45-degree field of view
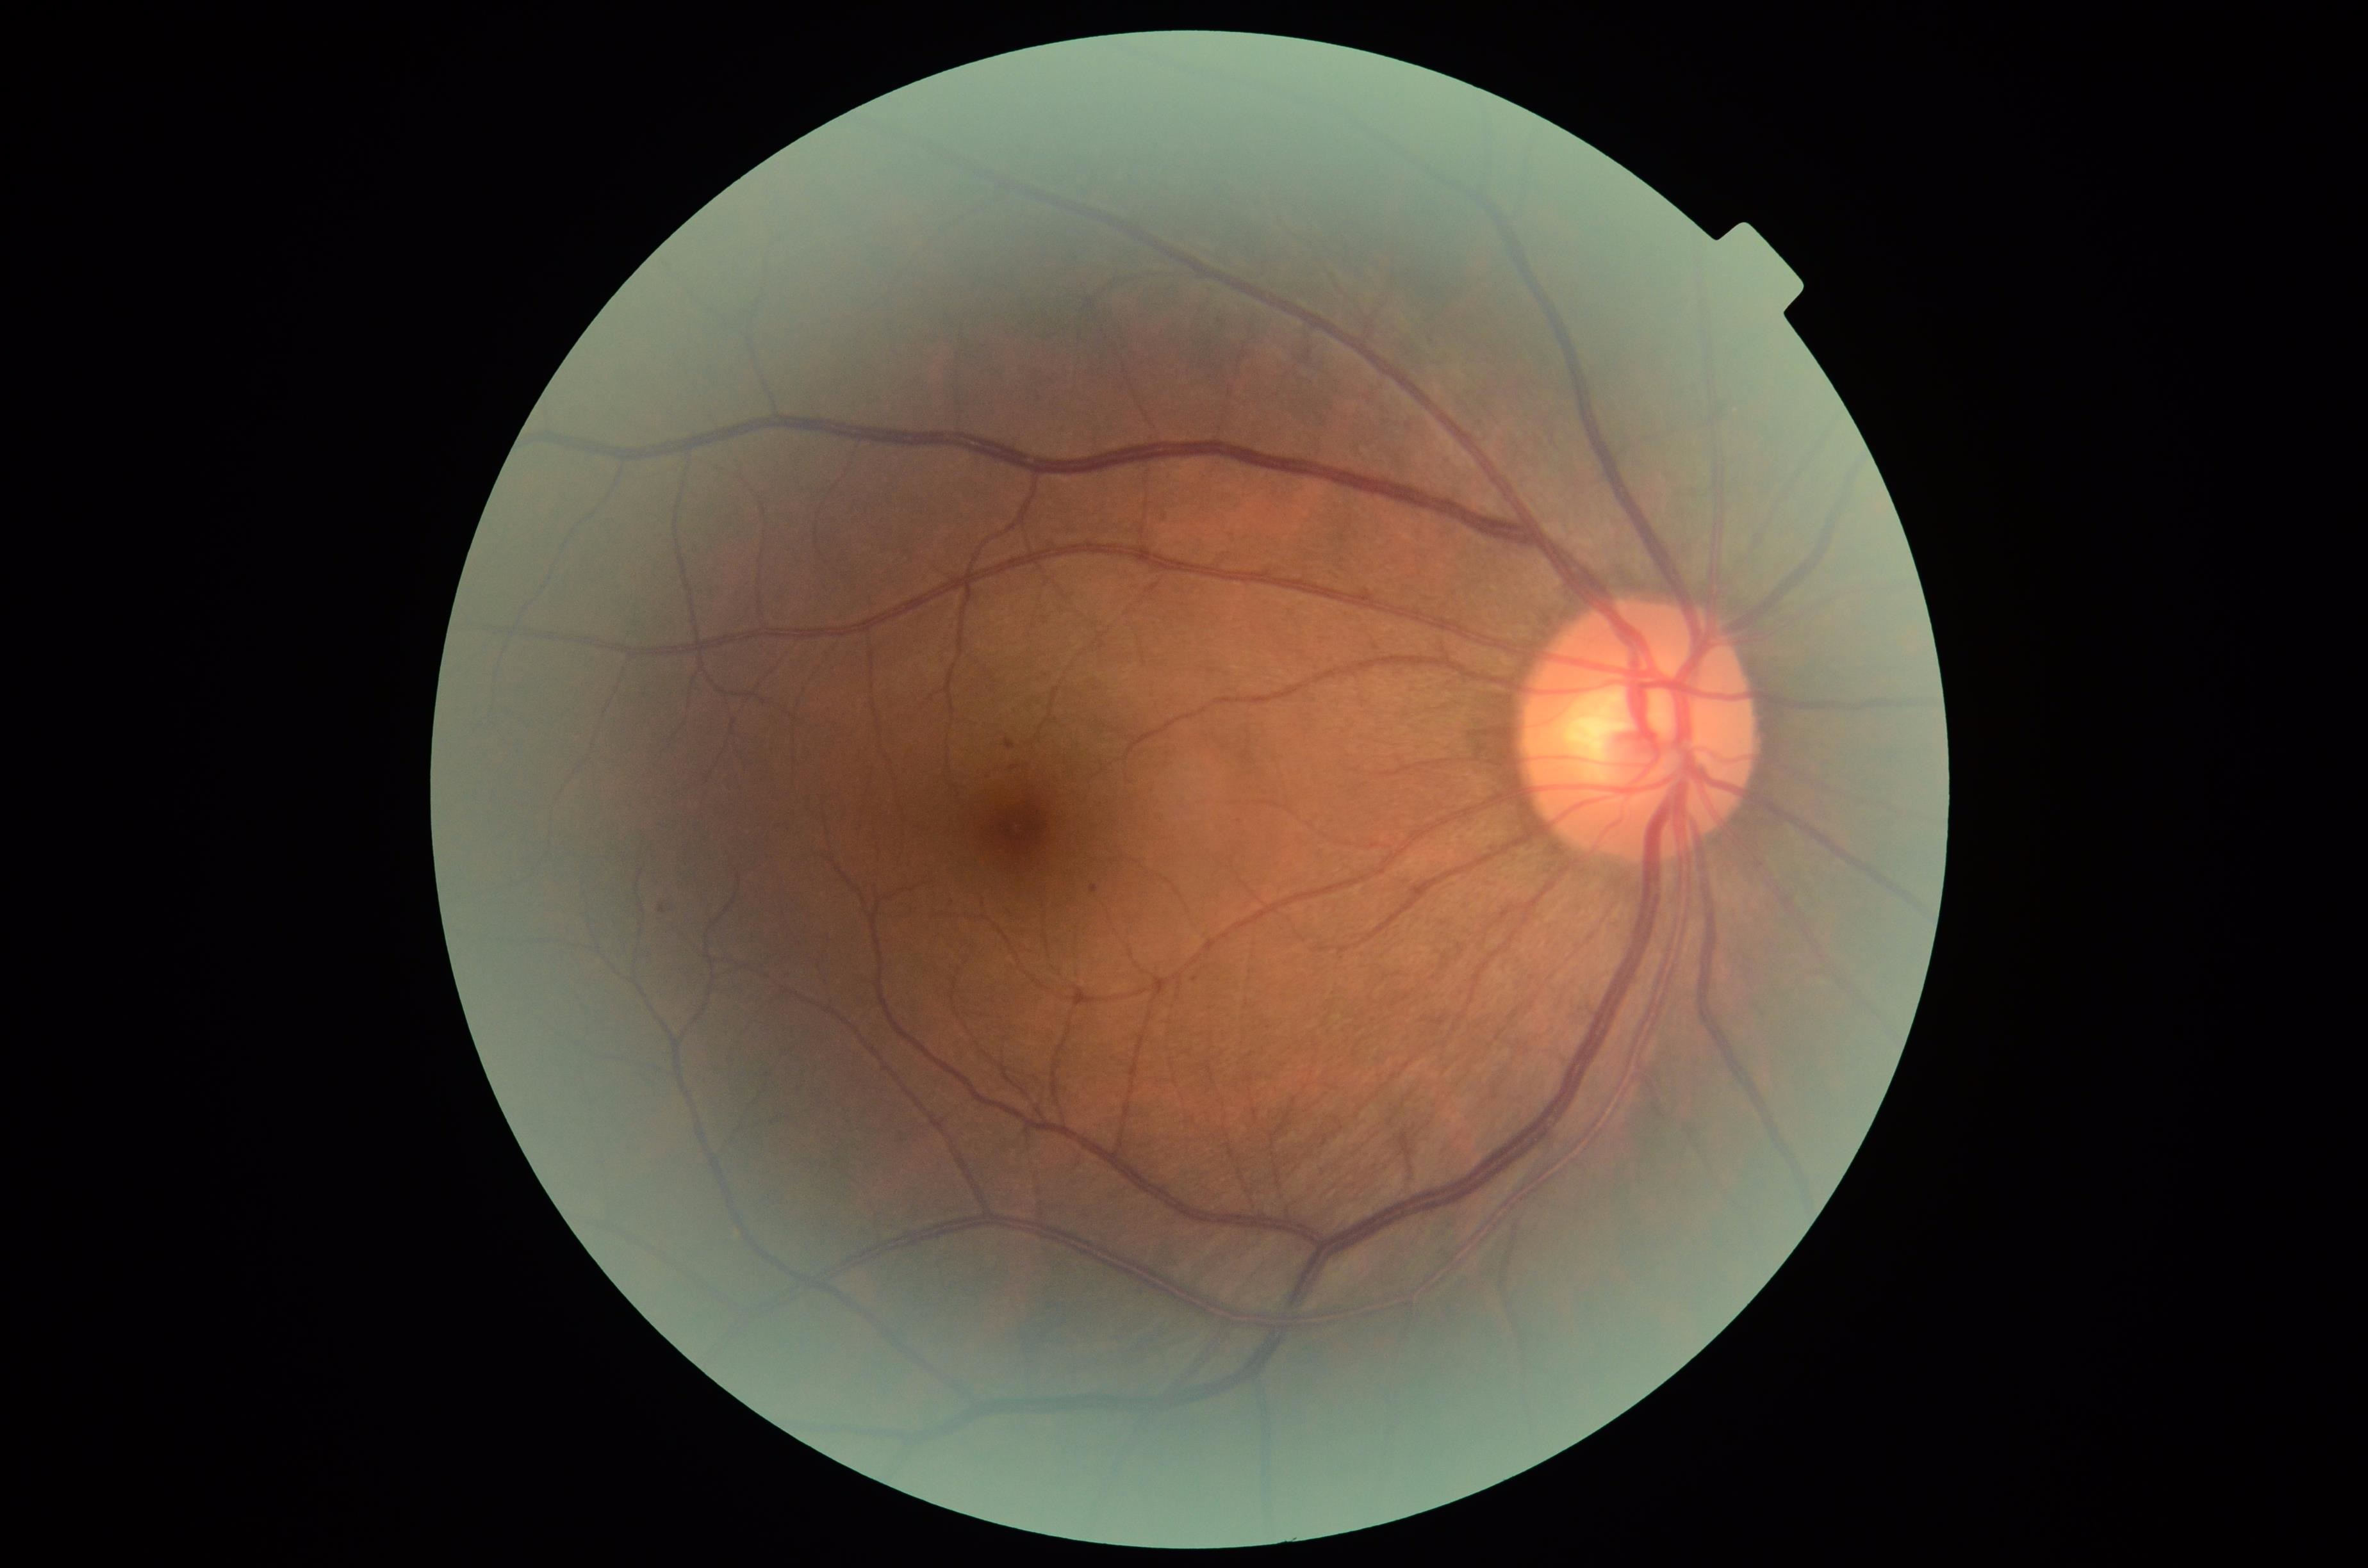

DR grade: 0.